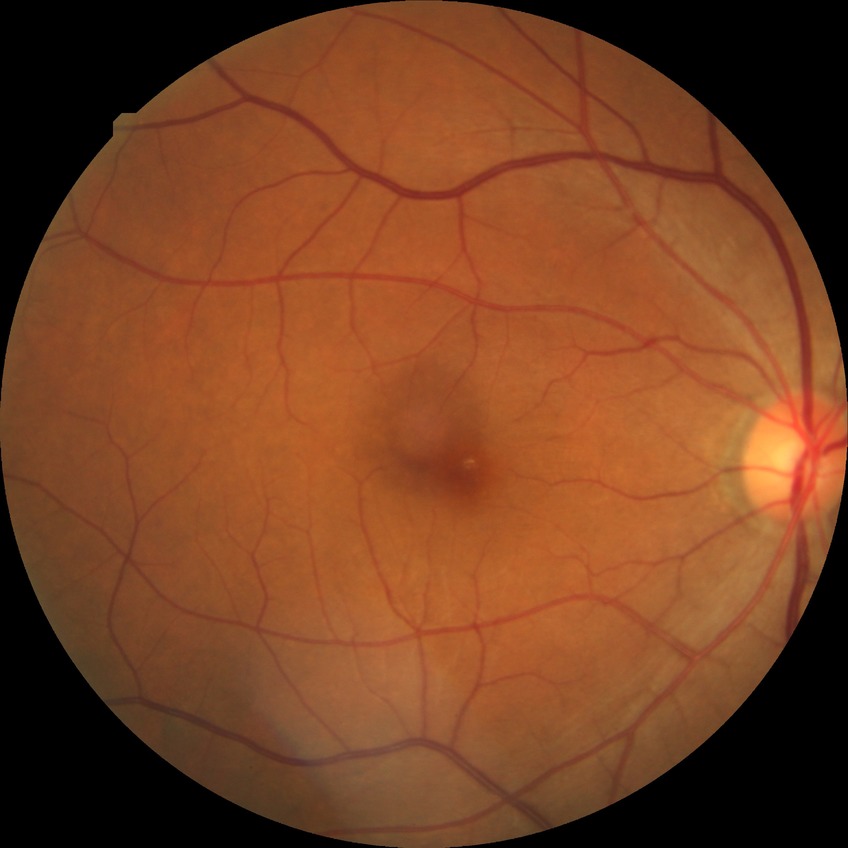

Findings:
– diabetic retinopathy (DR) — NDR (no diabetic retinopathy)